Retinal fundus photograph · 45° FOV:
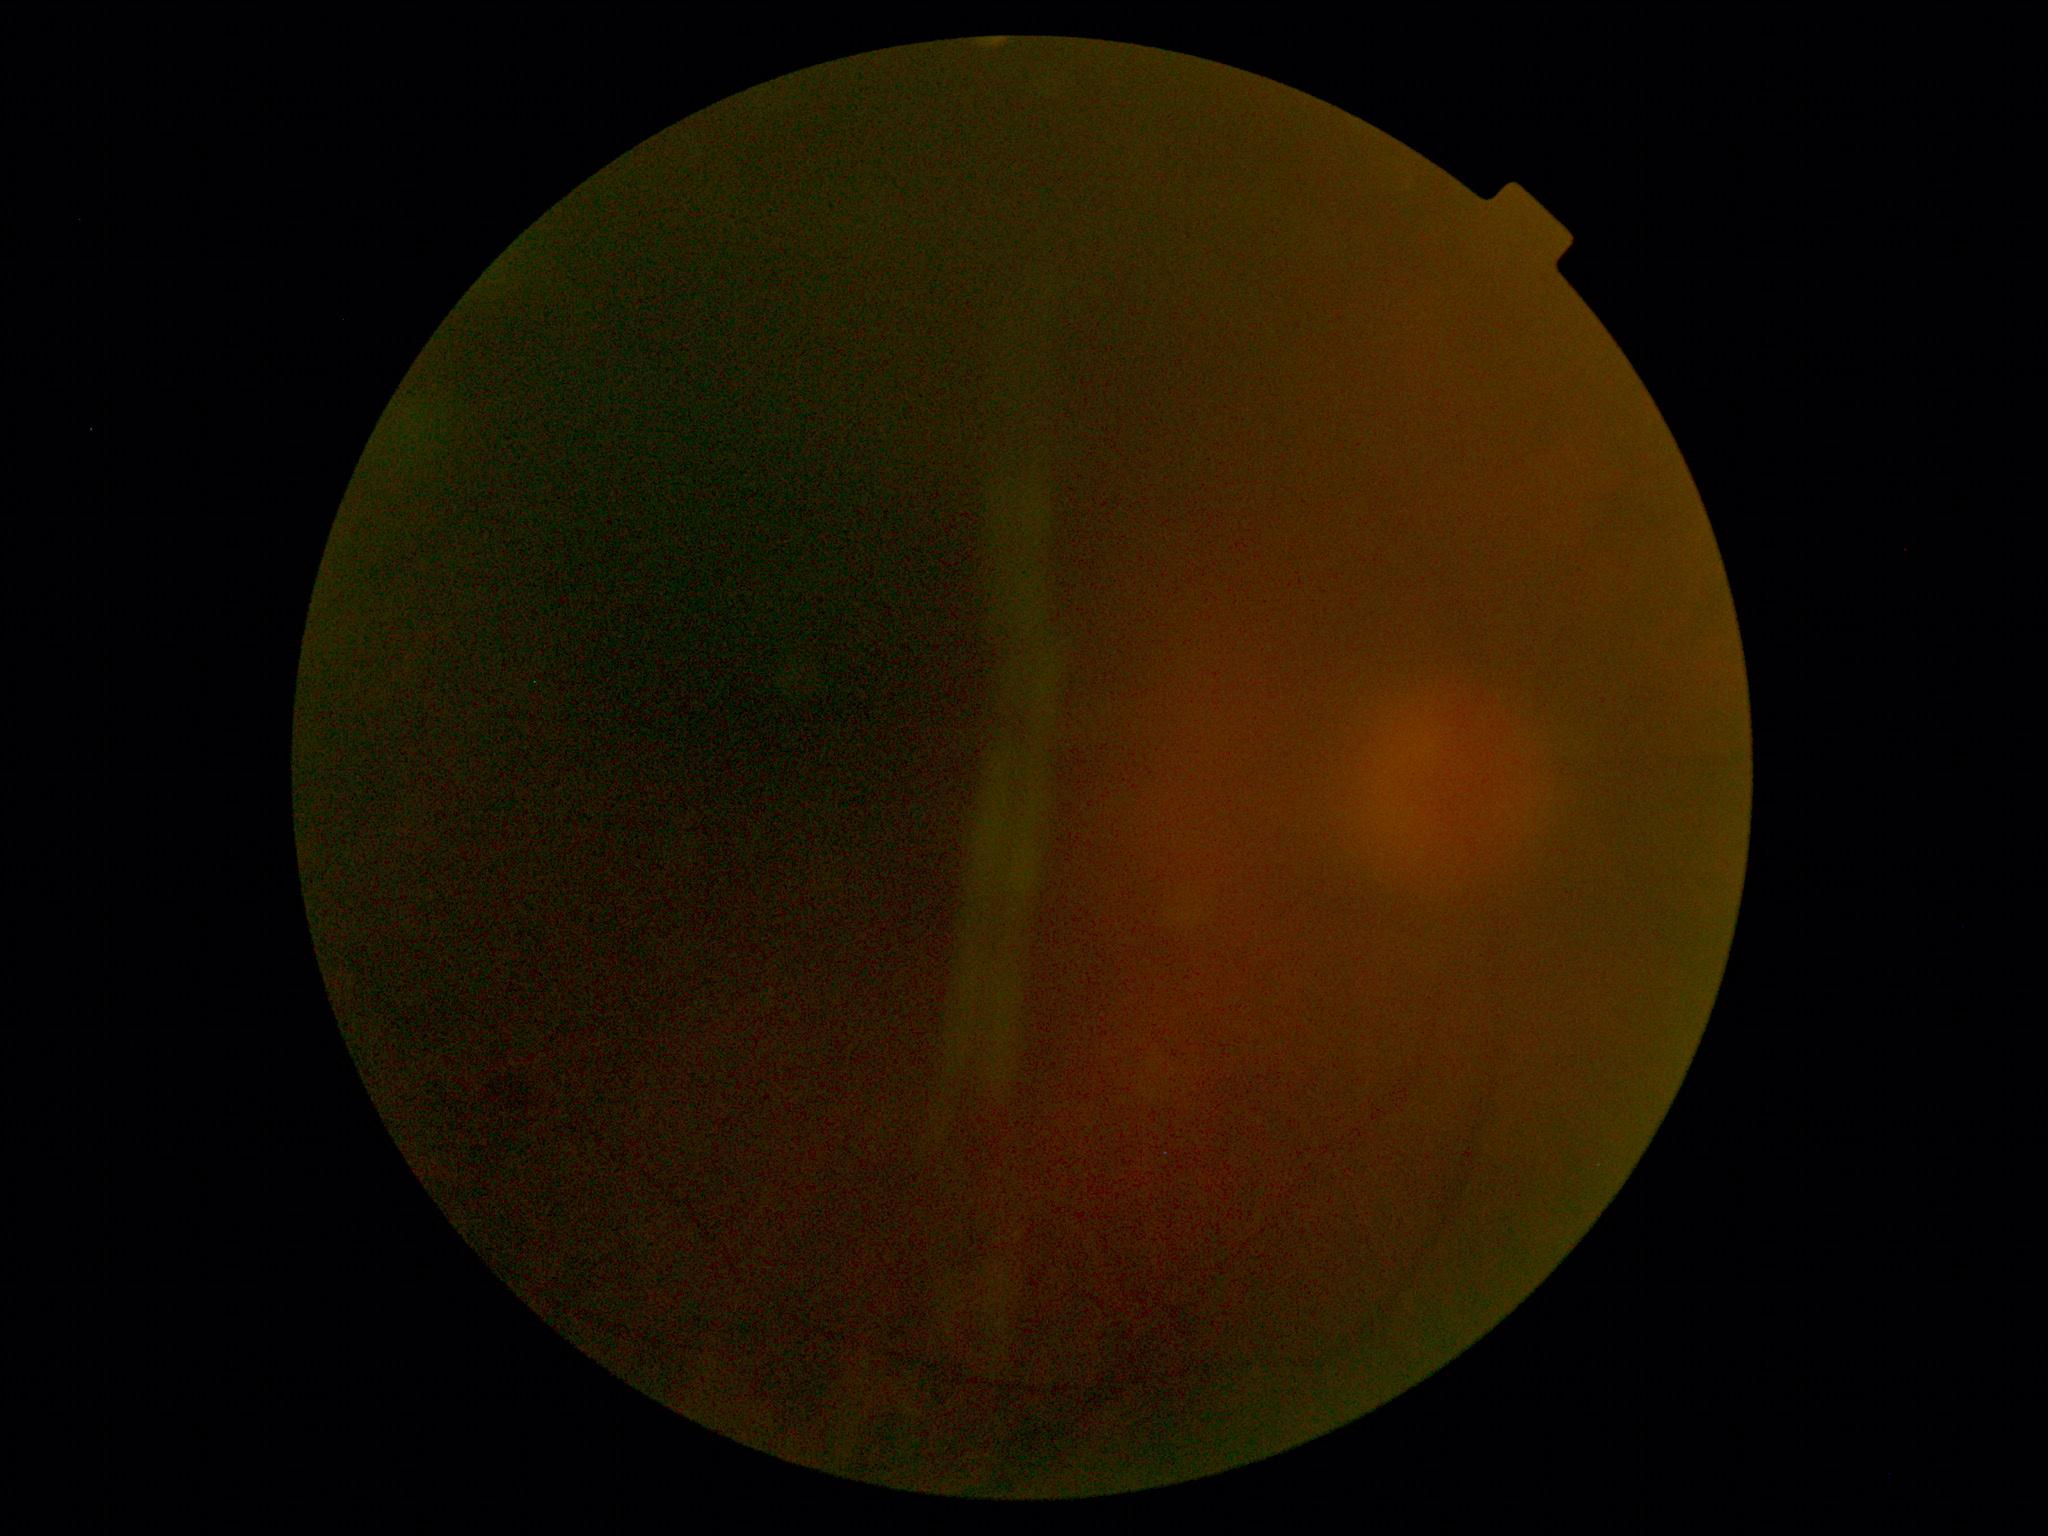

DR stage is ungradable due to poor image quality.